Davis DR grading
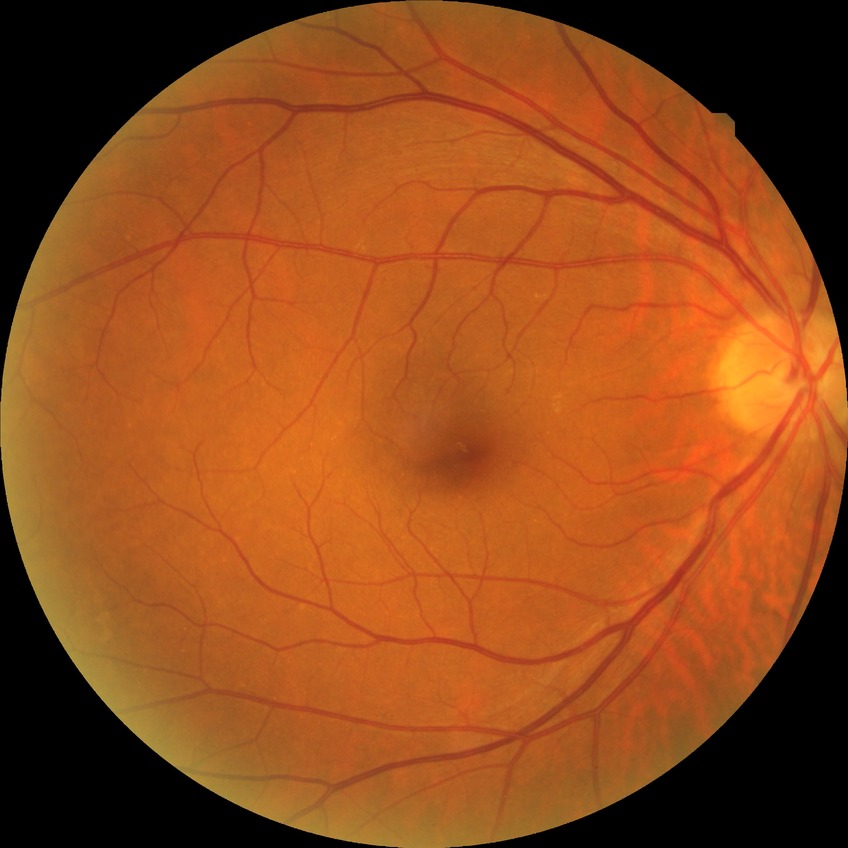 Diabetic retinopathy (DR) is no diabetic retinopathy (NDR).